Retinal fundus photograph
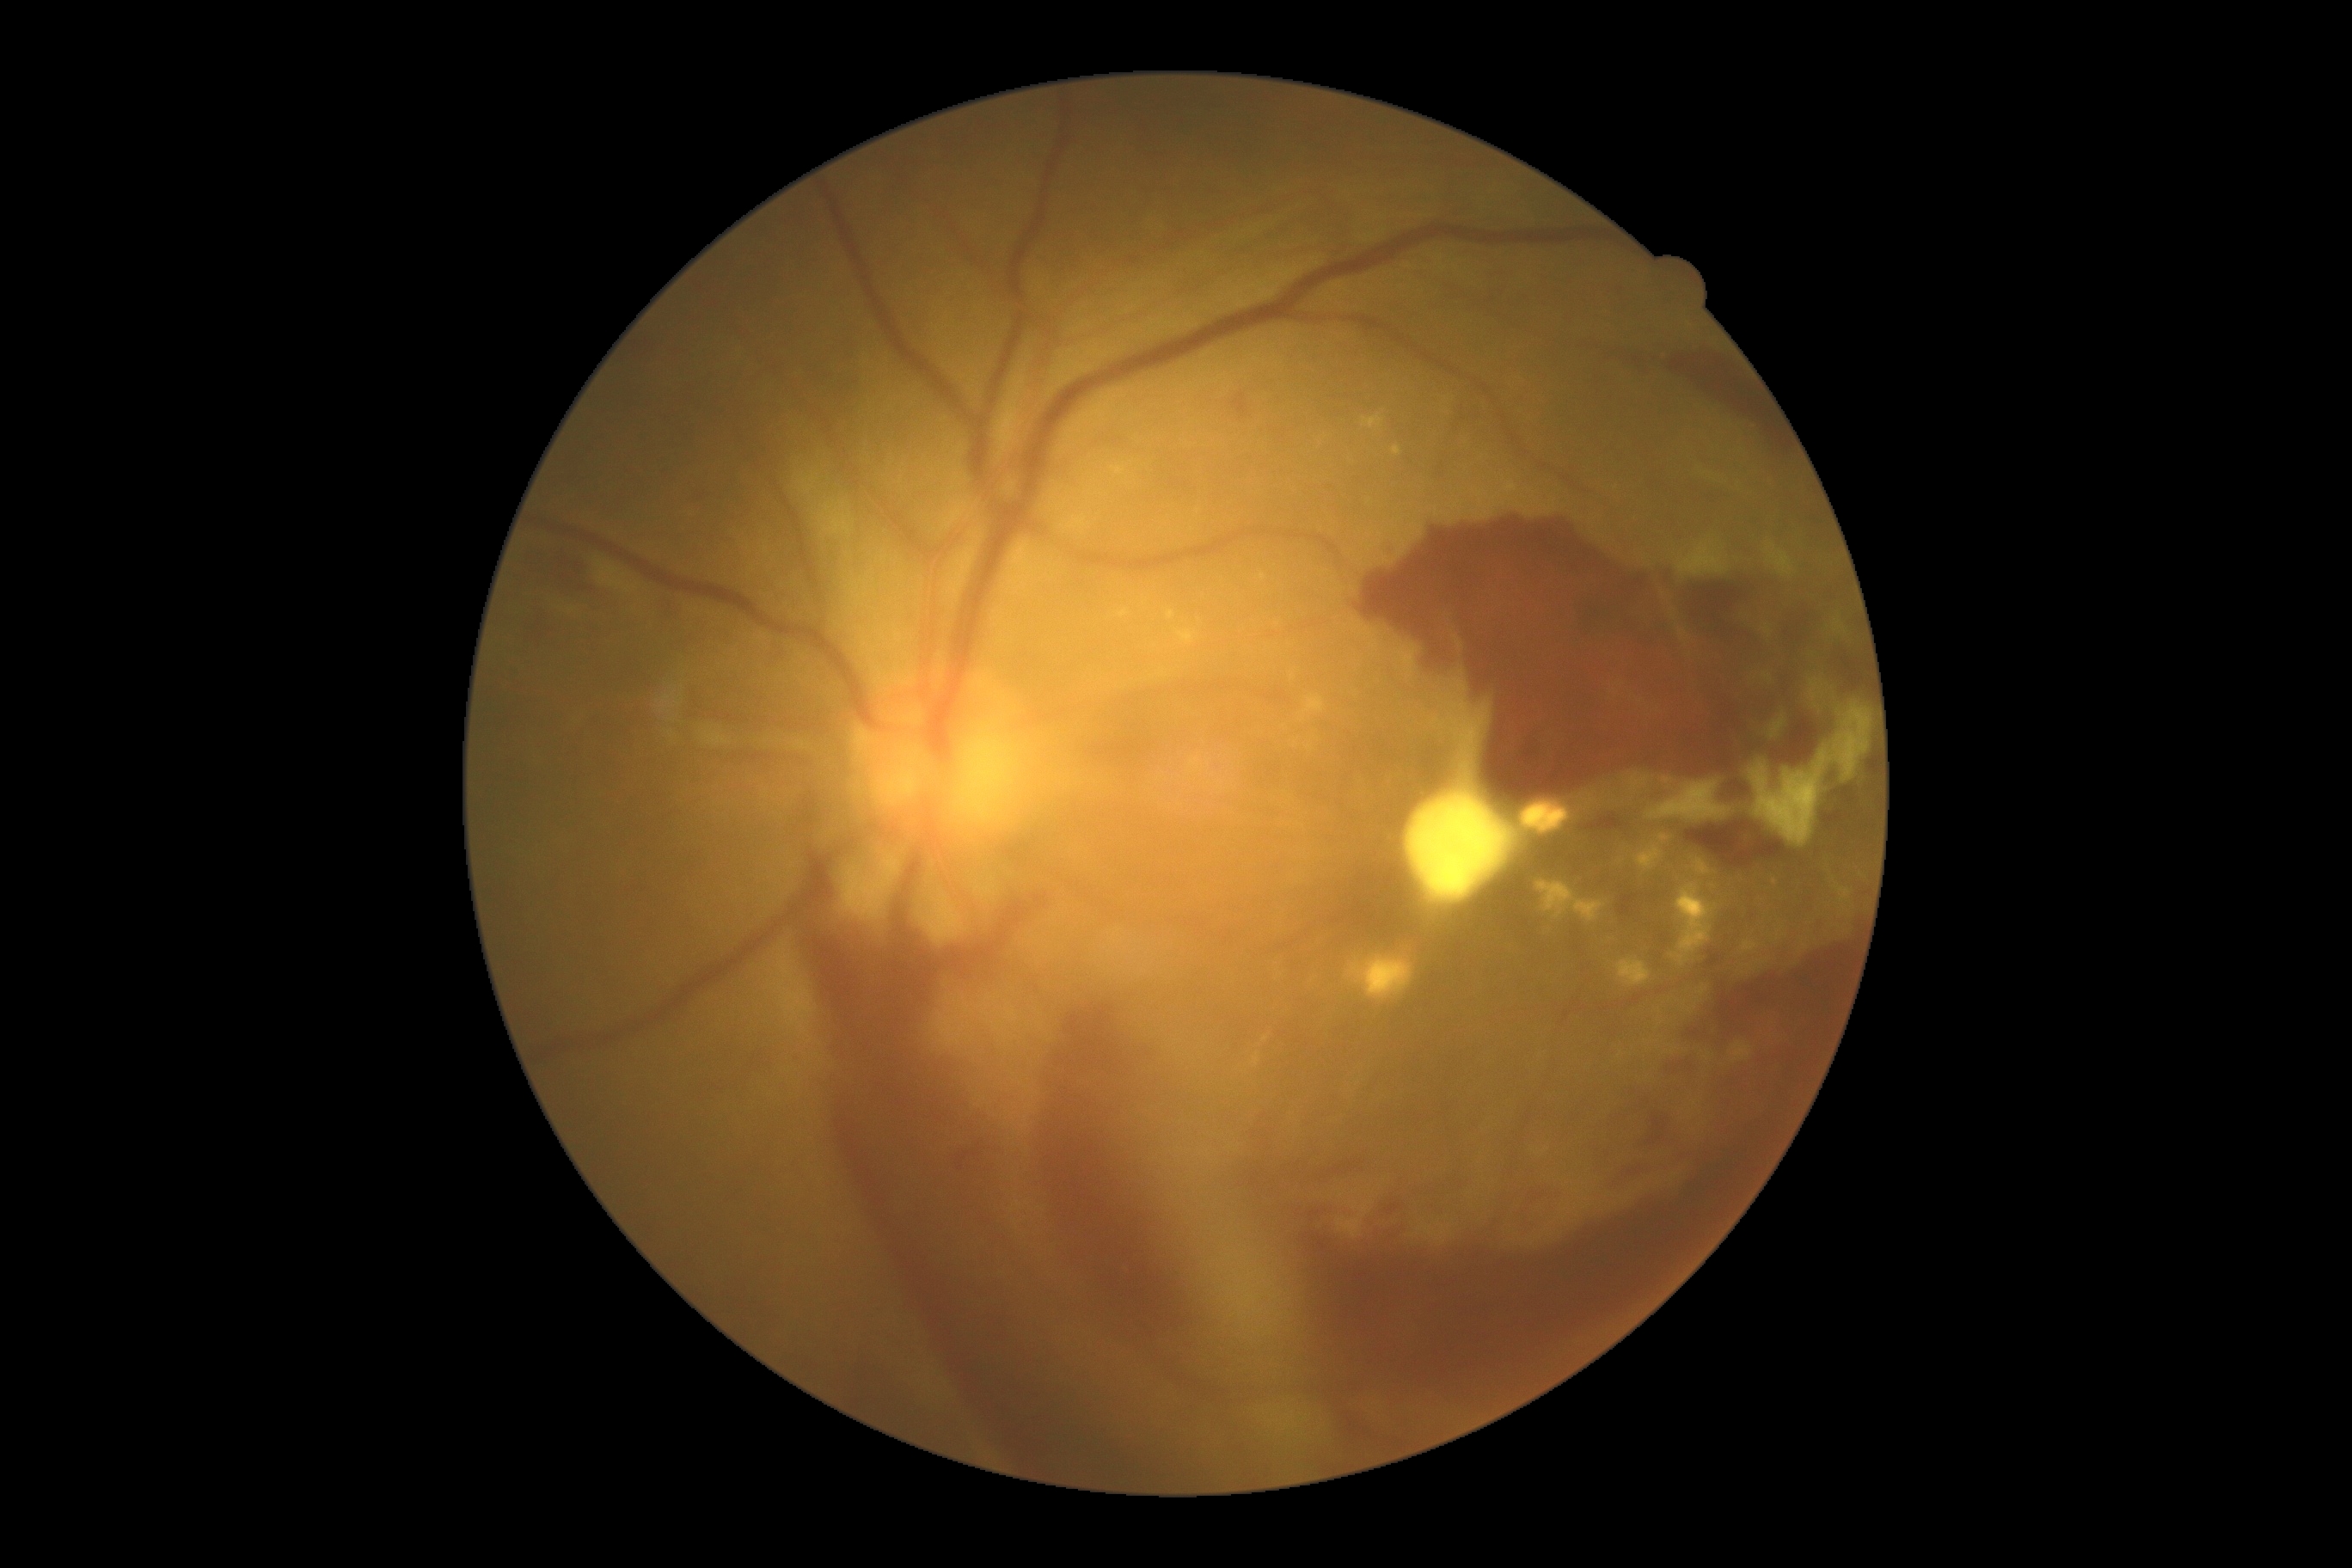 The retinopathy is classified as proliferative diabetic retinopathy.
Diabetic retinopathy (DR): 4 — neovascularization and/or vitreous/pre-retinal hemorrhage.